Optic disc photograph:
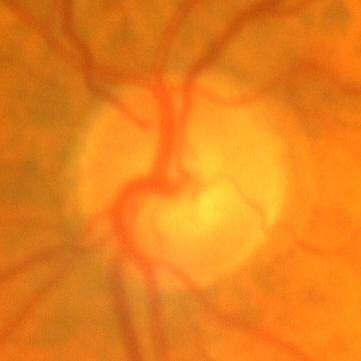
Glaucoma diagnosis = no signs of glaucoma.